Diabetic retinopathy graded by the modified Davis classification: 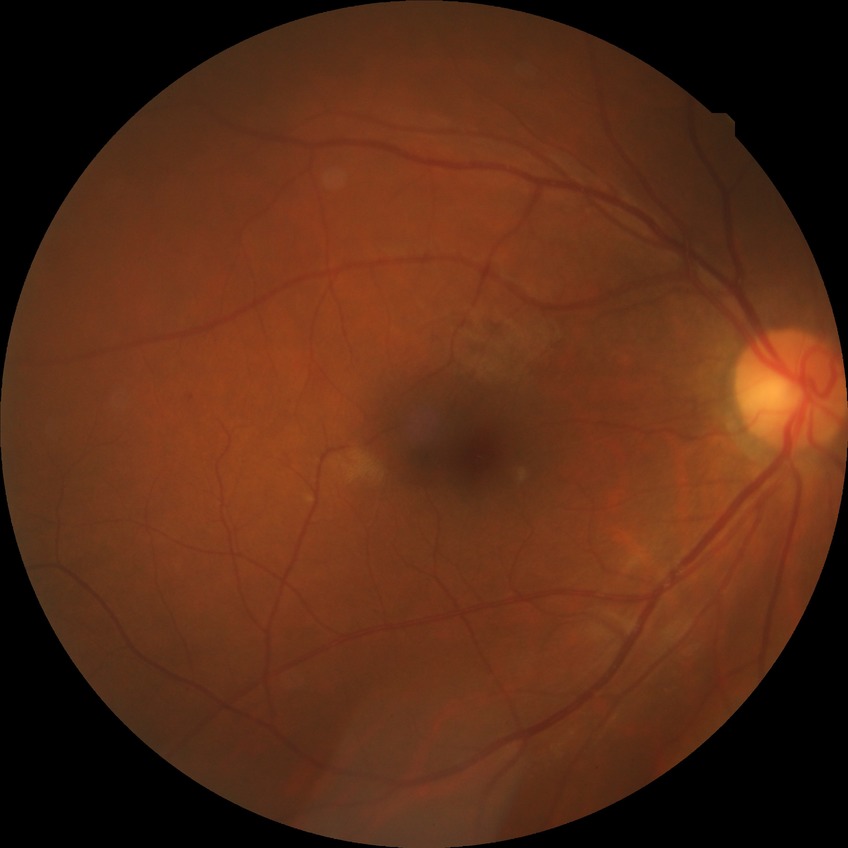
* diabetic retinopathy (DR) — NDR (no diabetic retinopathy)